Graded on the modified Davis scale
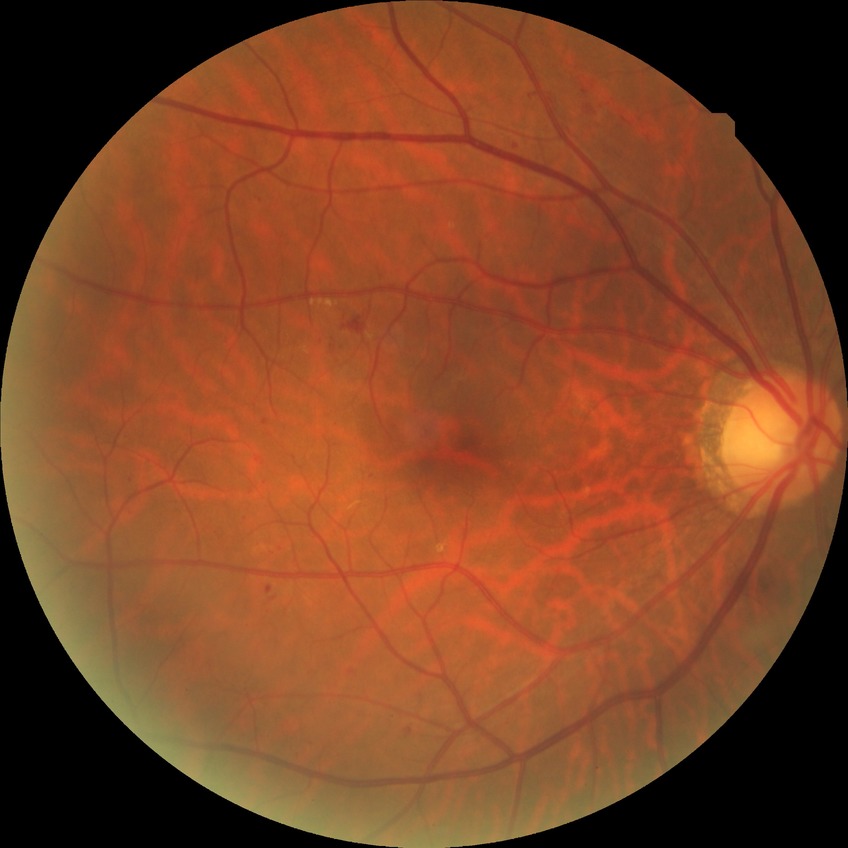 diabetic retinopathy (DR)=SDR (simple diabetic retinopathy).